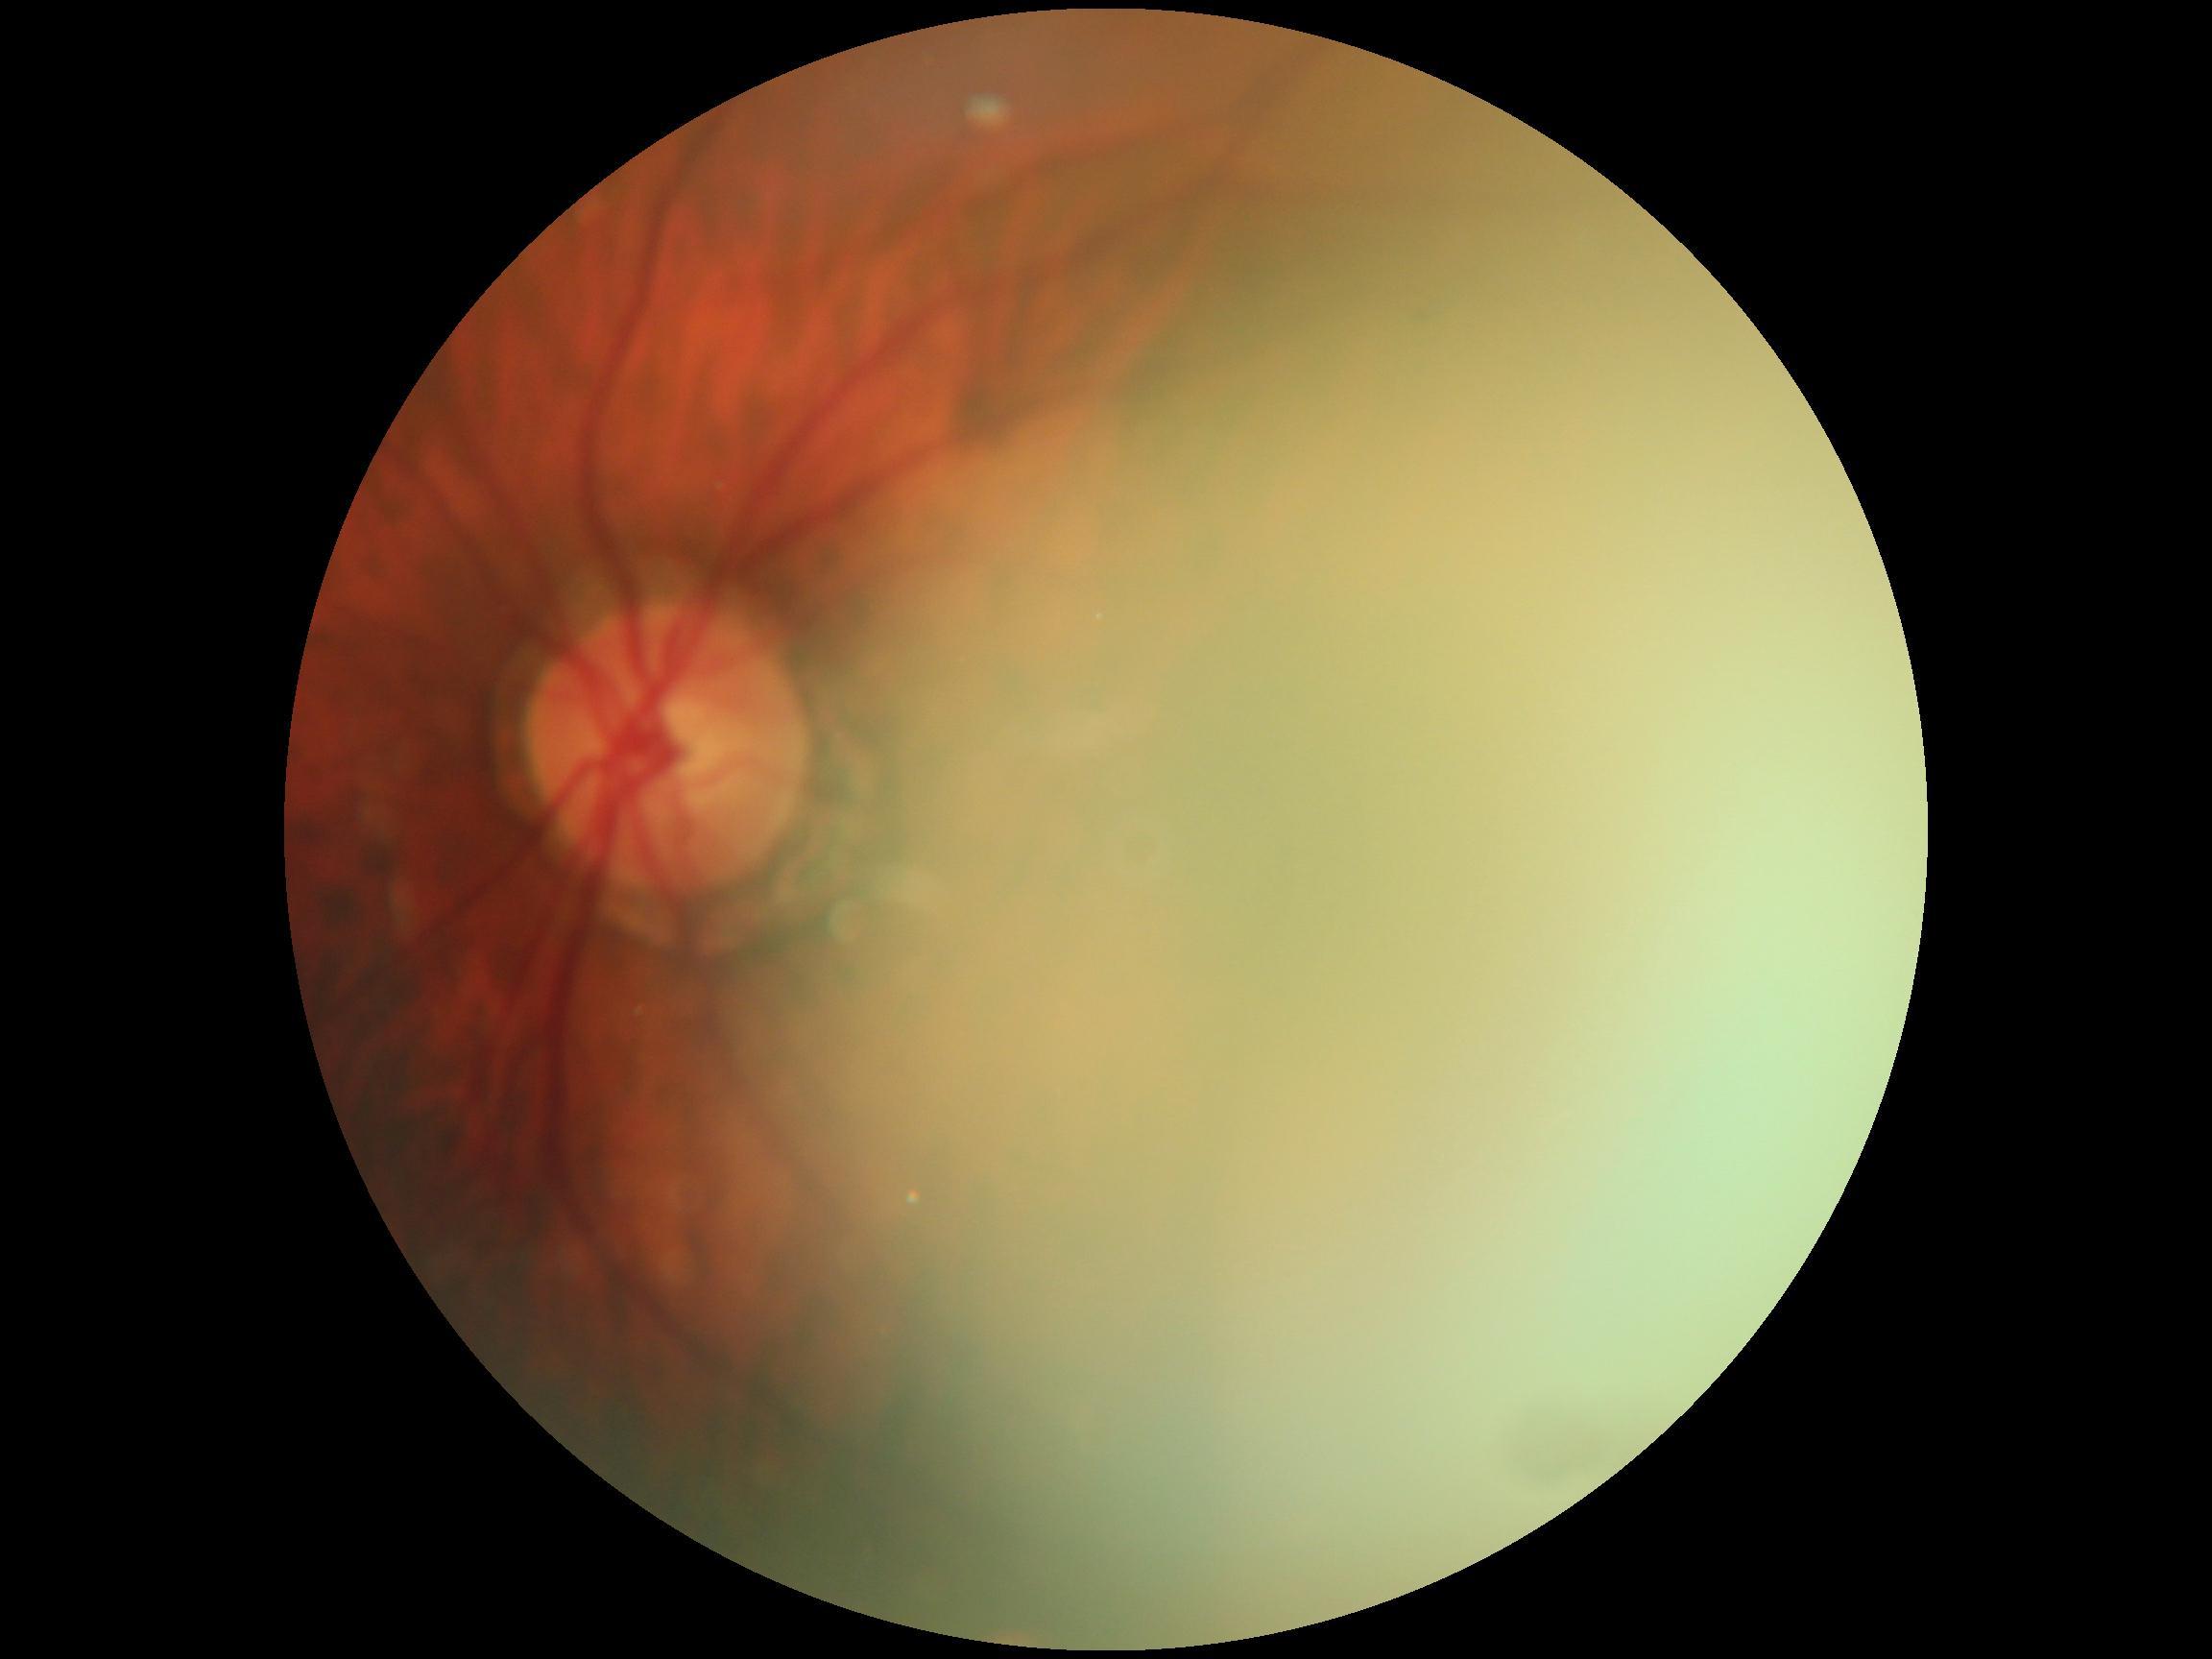

dr_grade: ungradable